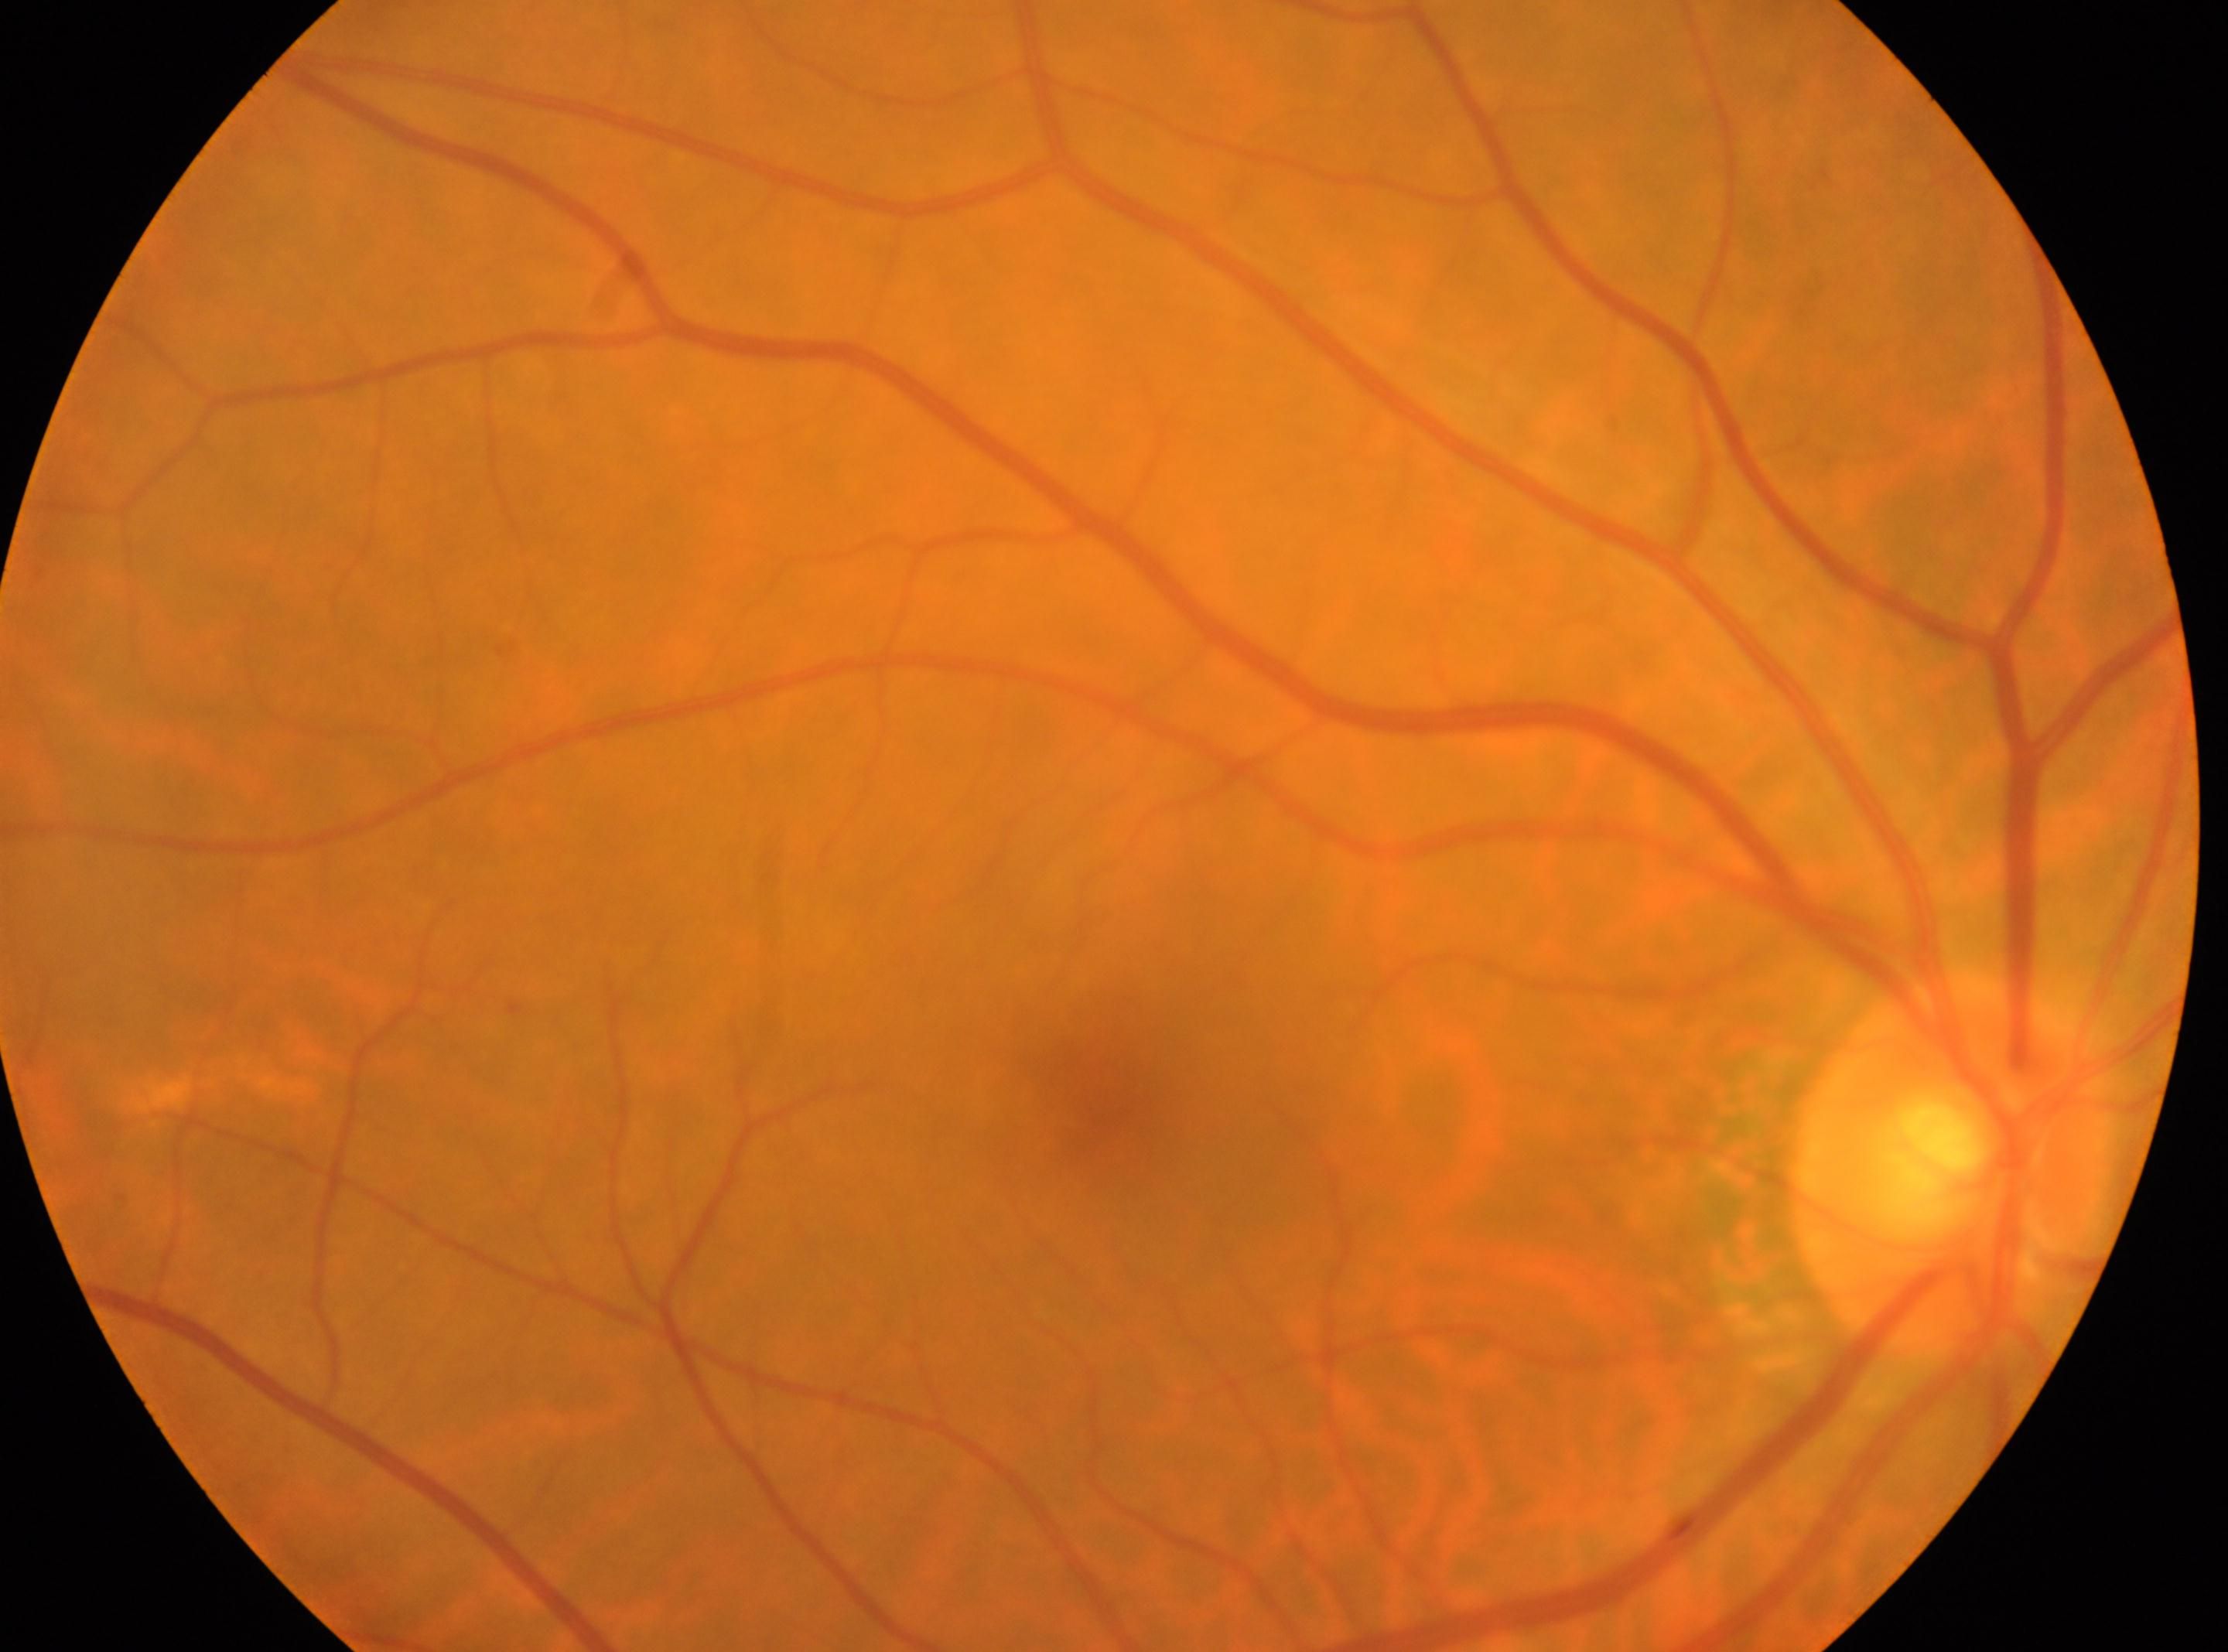 Diabetic retinopathy (DR) is grade 0 (no apparent retinopathy).
The fovea center is at (1102,1098).
Optic disc: (1950,1163).
The image shows the right eye.